1380 by 1382 pixels. Color fundus photograph. 45-degree field of view.
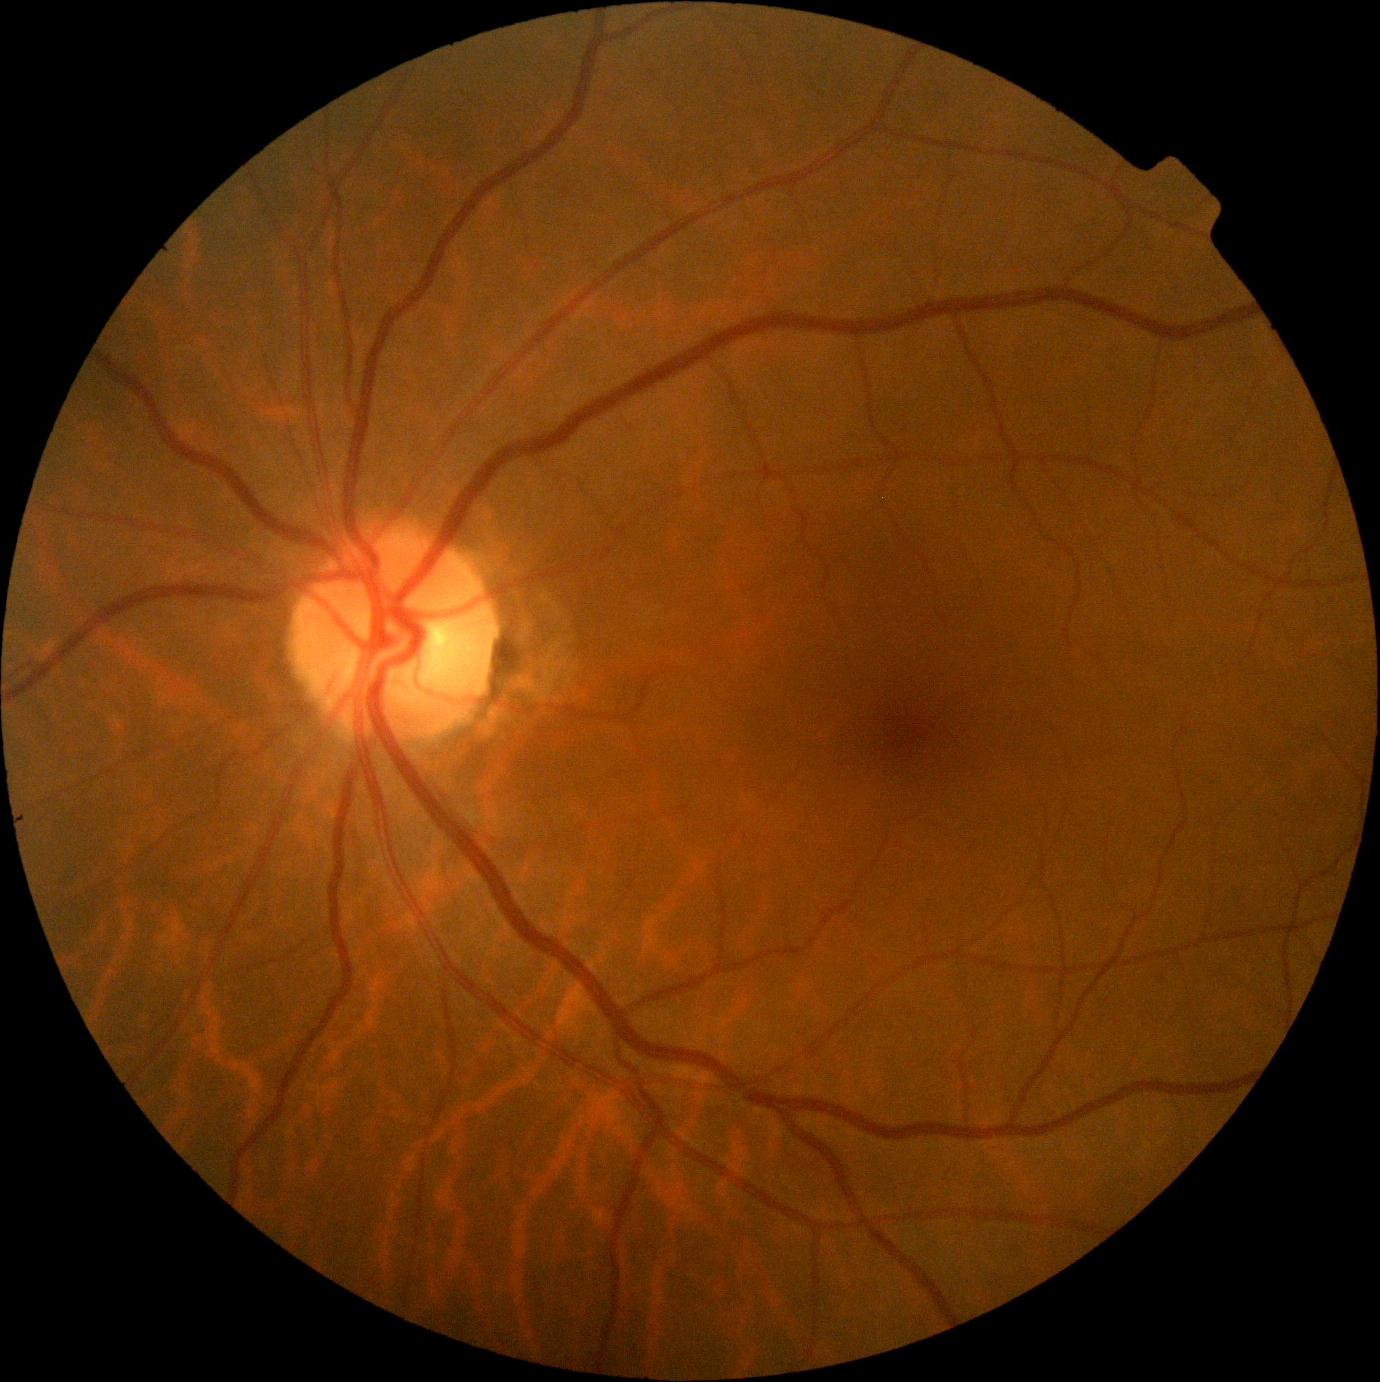
DR = no apparent diabetic retinopathy (grade 0).